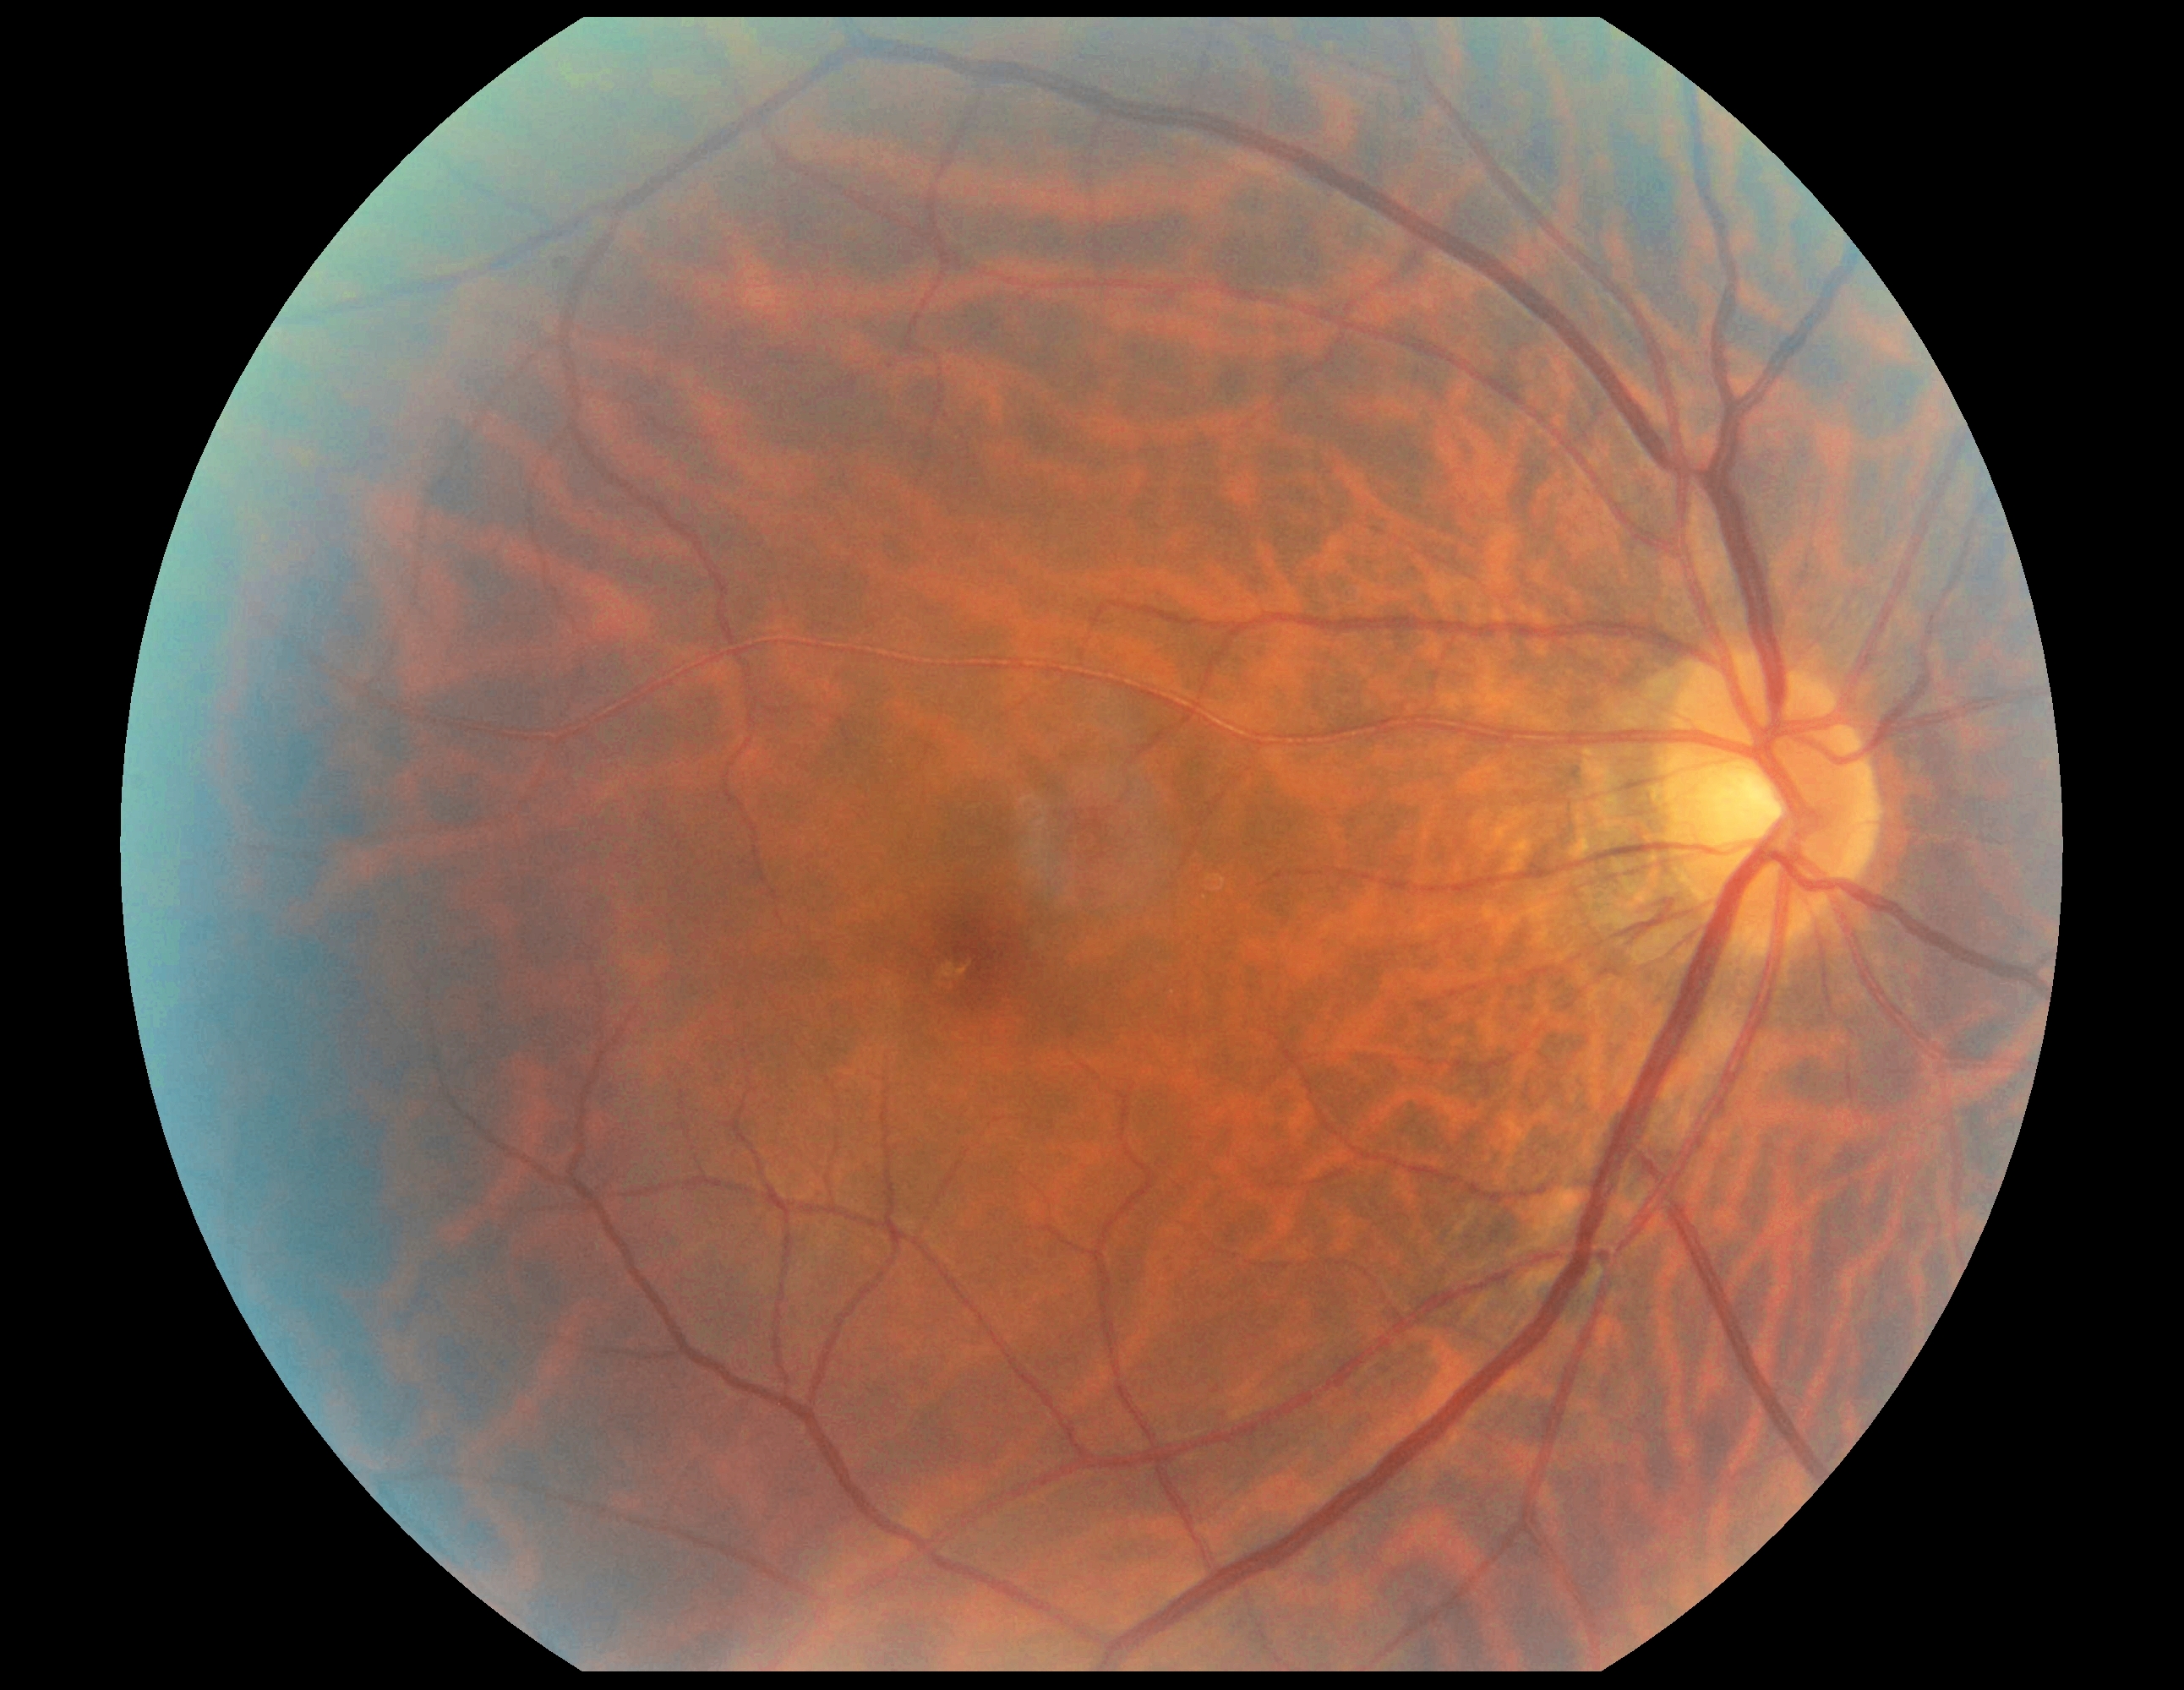
Diabetic retinopathy grade: no apparent diabetic retinopathy (0).